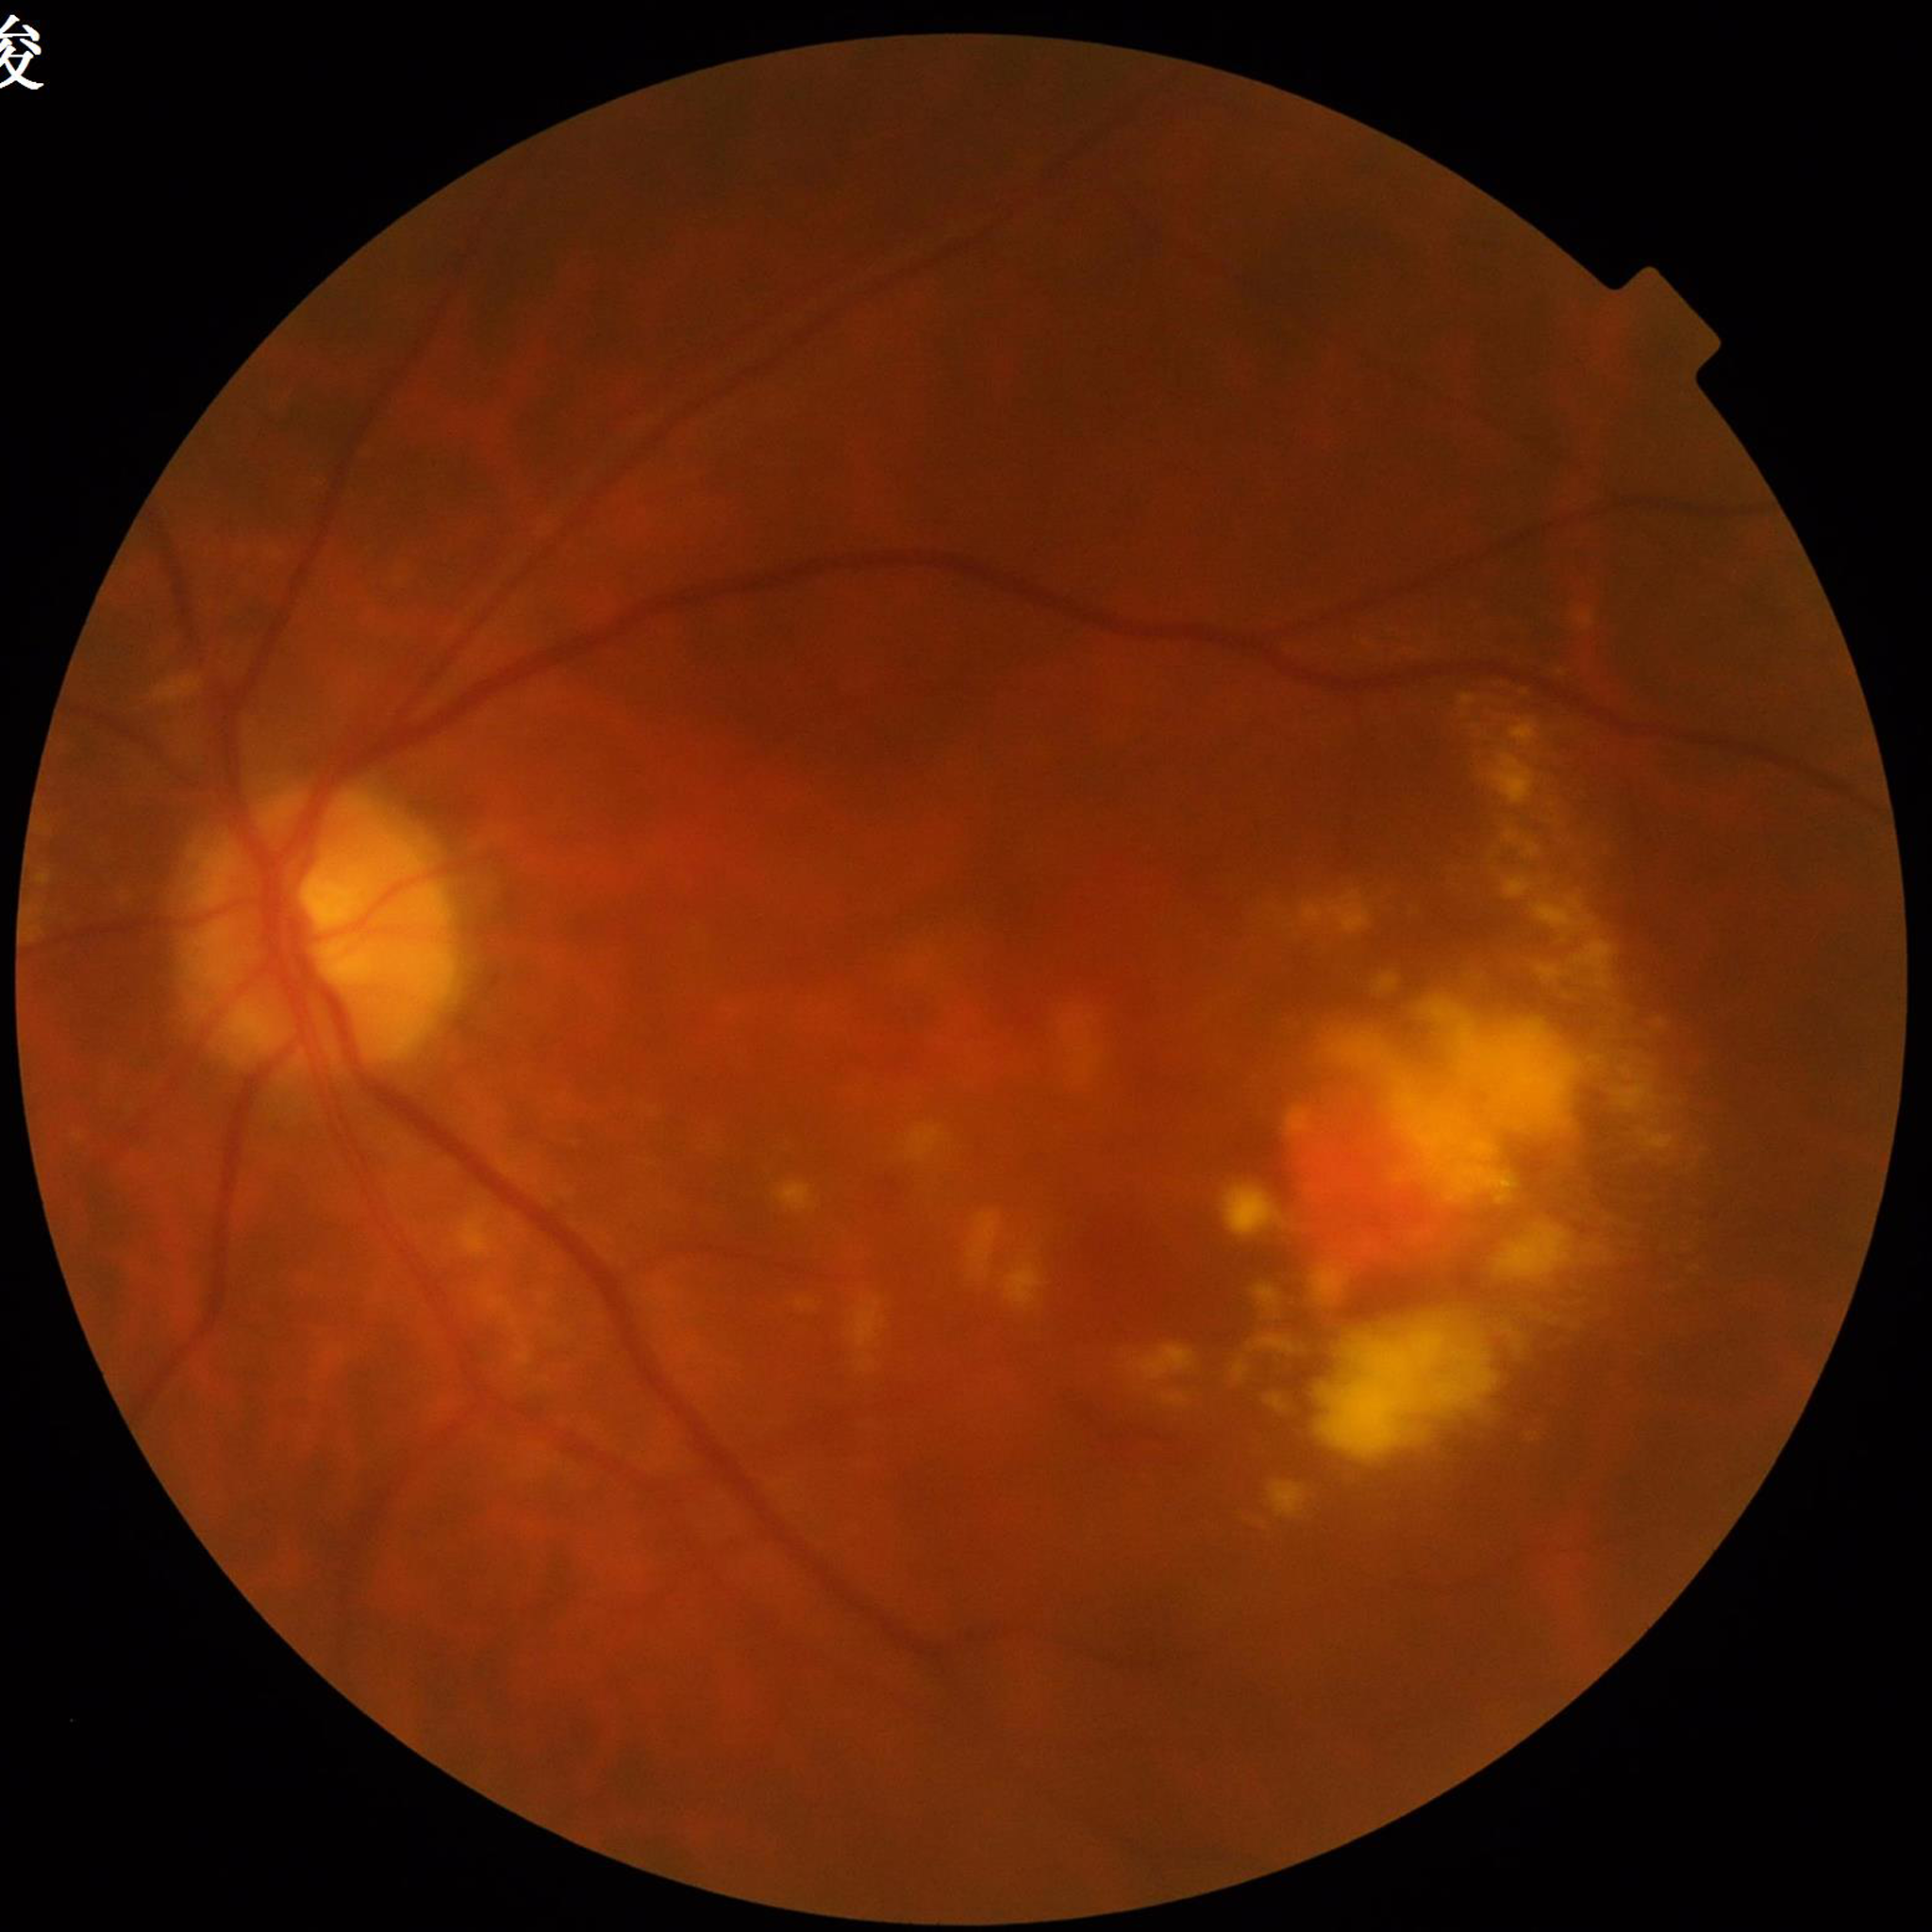
Image quality: suboptimal — blur. From a patient with age-related macular degeneration (AMD).